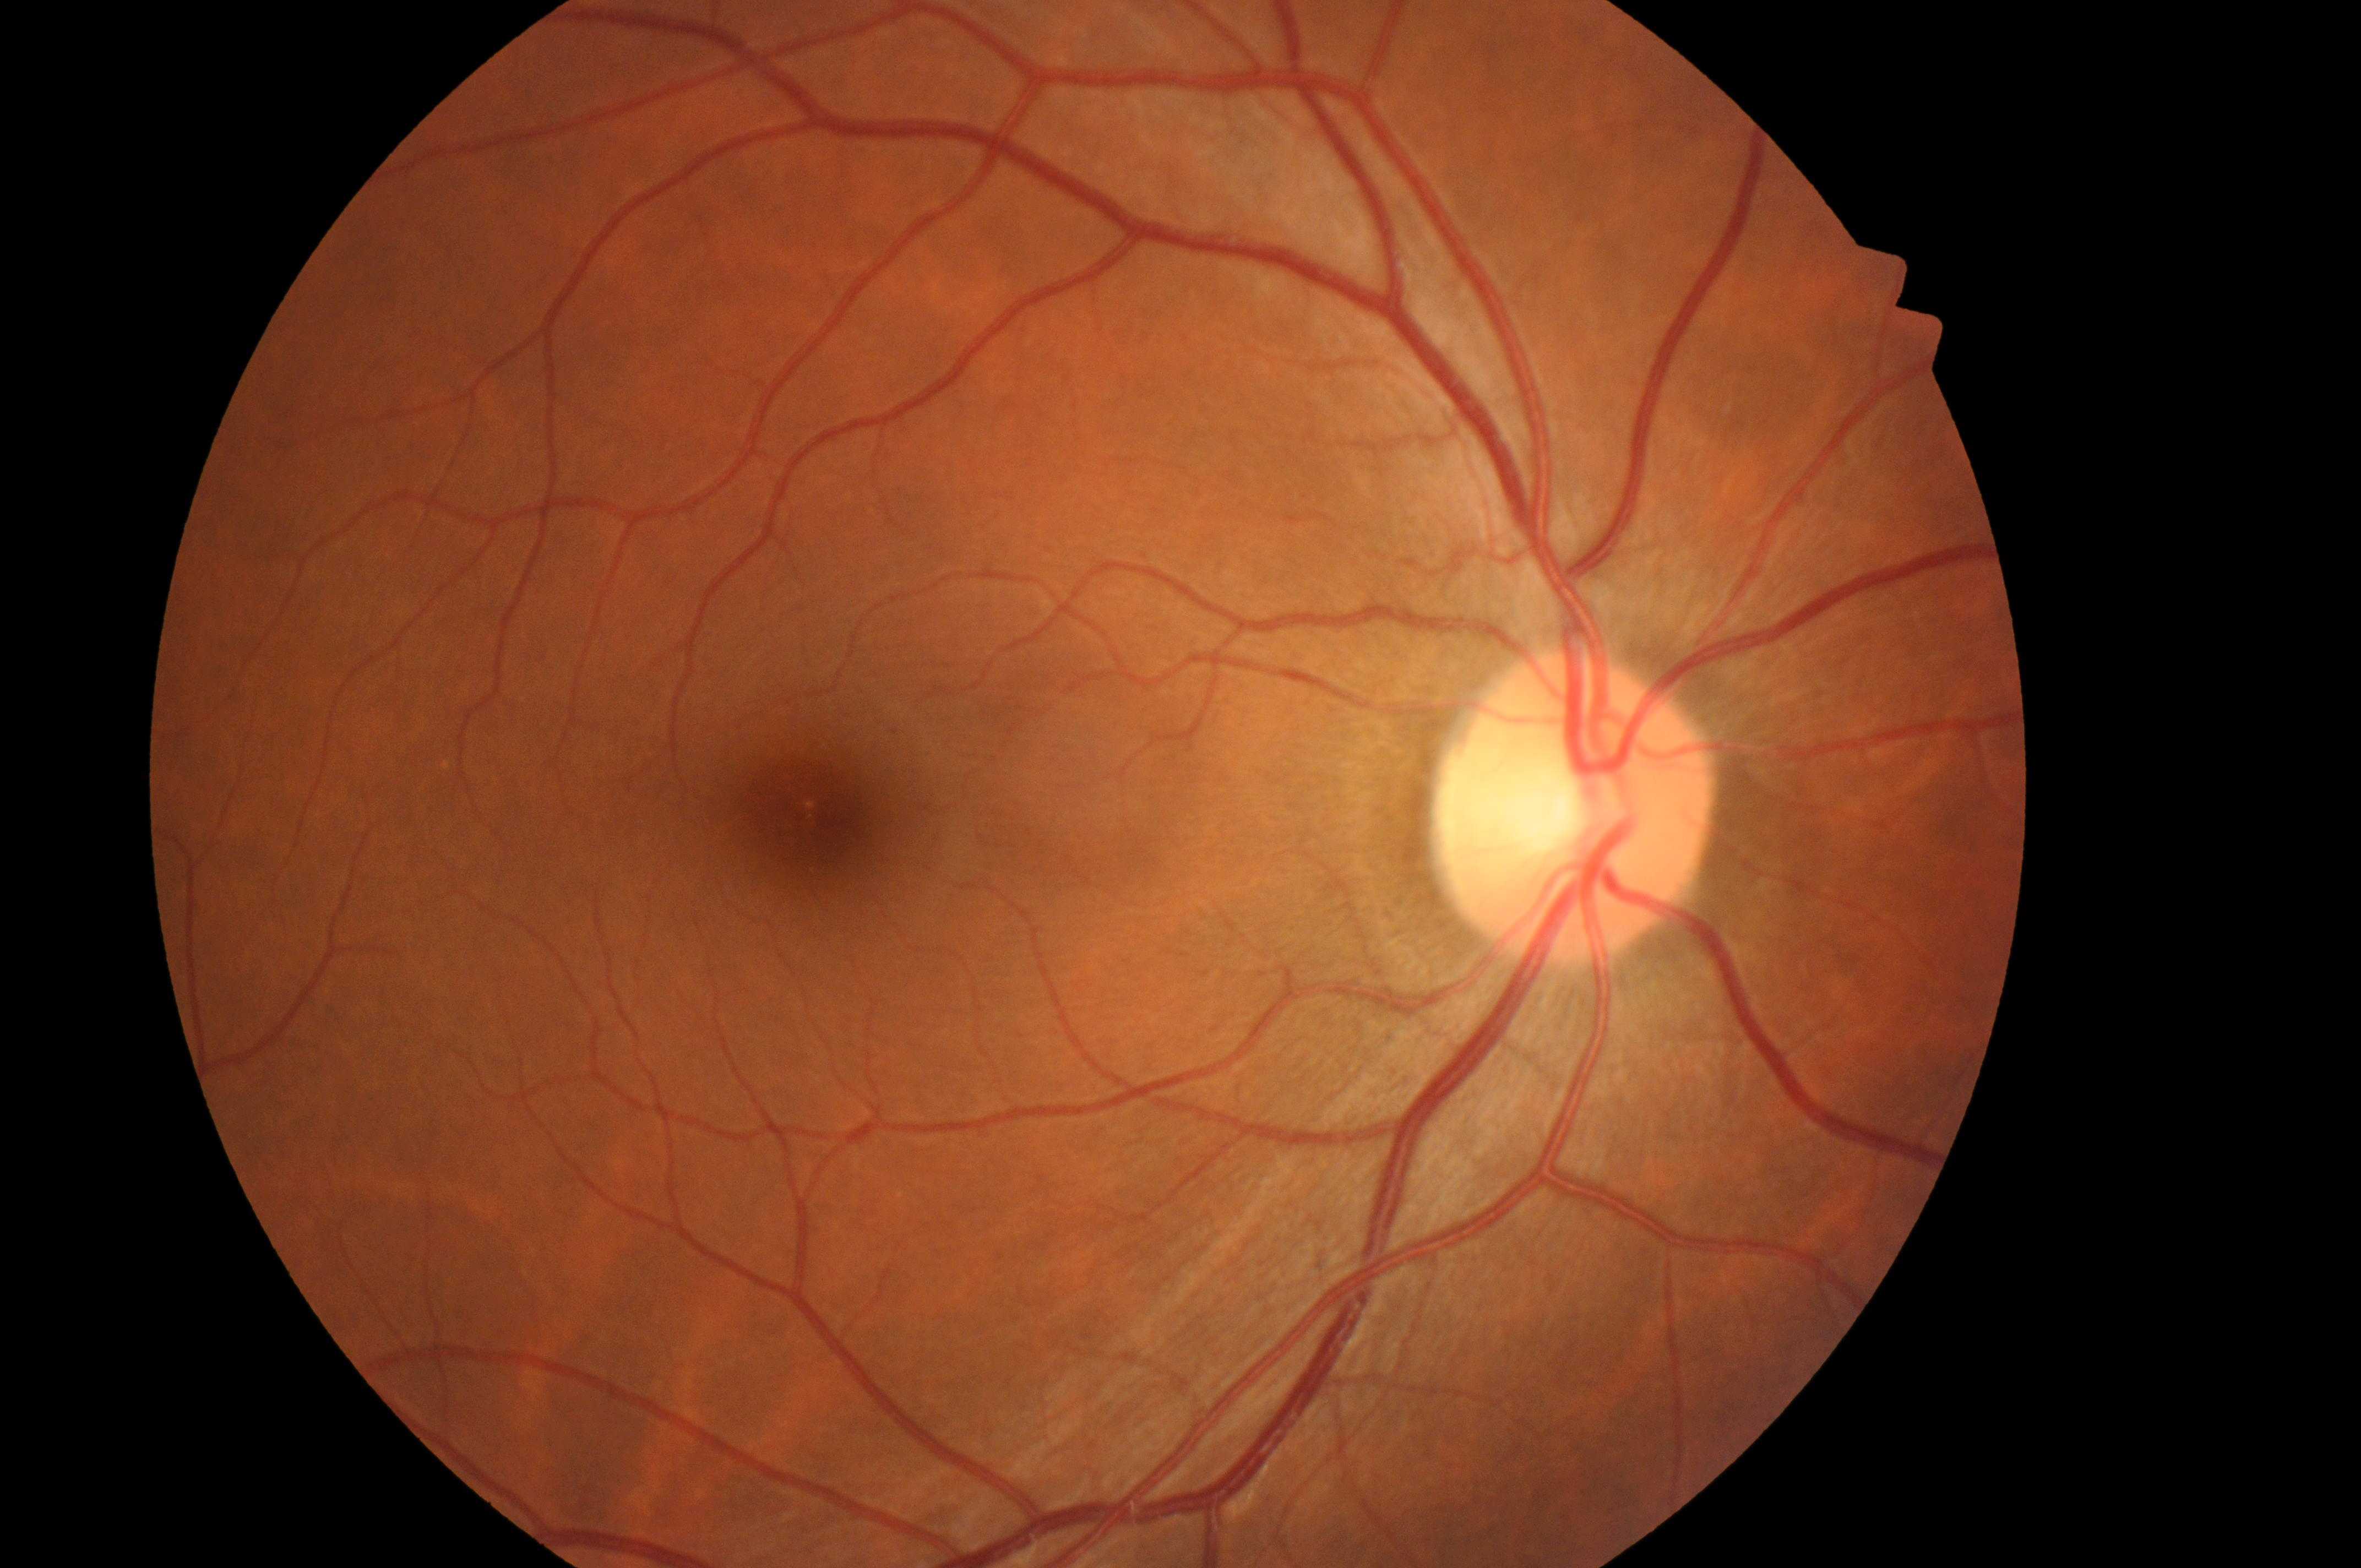 ONH: [1565, 818]. Risk of diabetic macular edema is no risk (grade 0). The fovea center is at [817, 829]. Eye: right eye. Diabetic retinopathy severity is grade 0 (no apparent retinopathy).